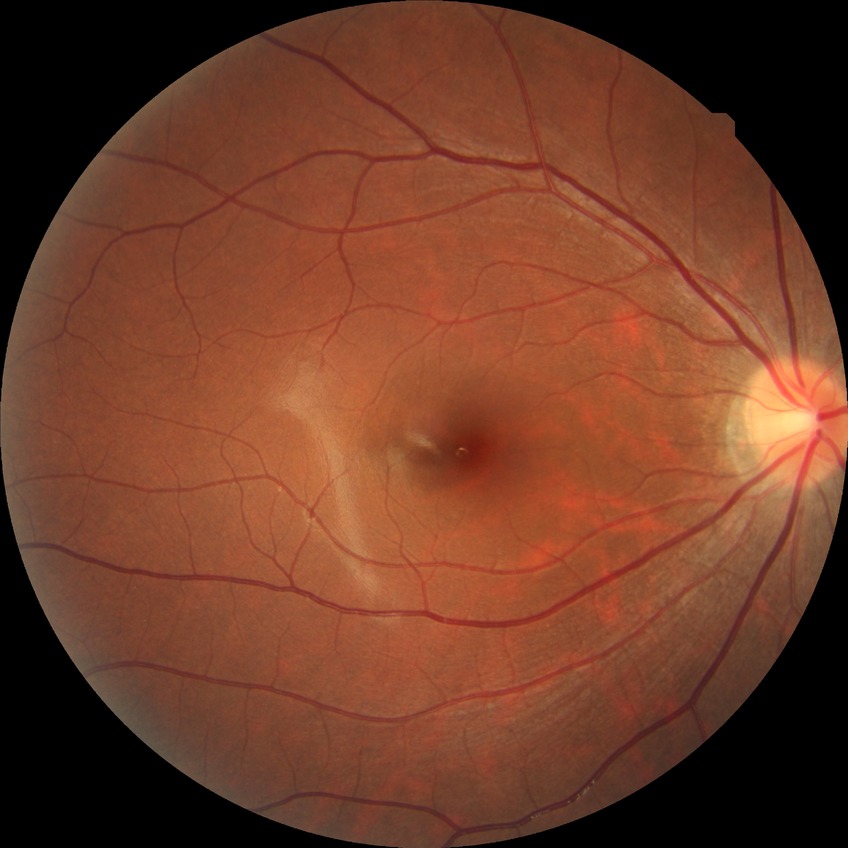

diabetic retinopathy (DR)=NDR (no diabetic retinopathy).